45° FOV; 2352 by 1568 pixels.
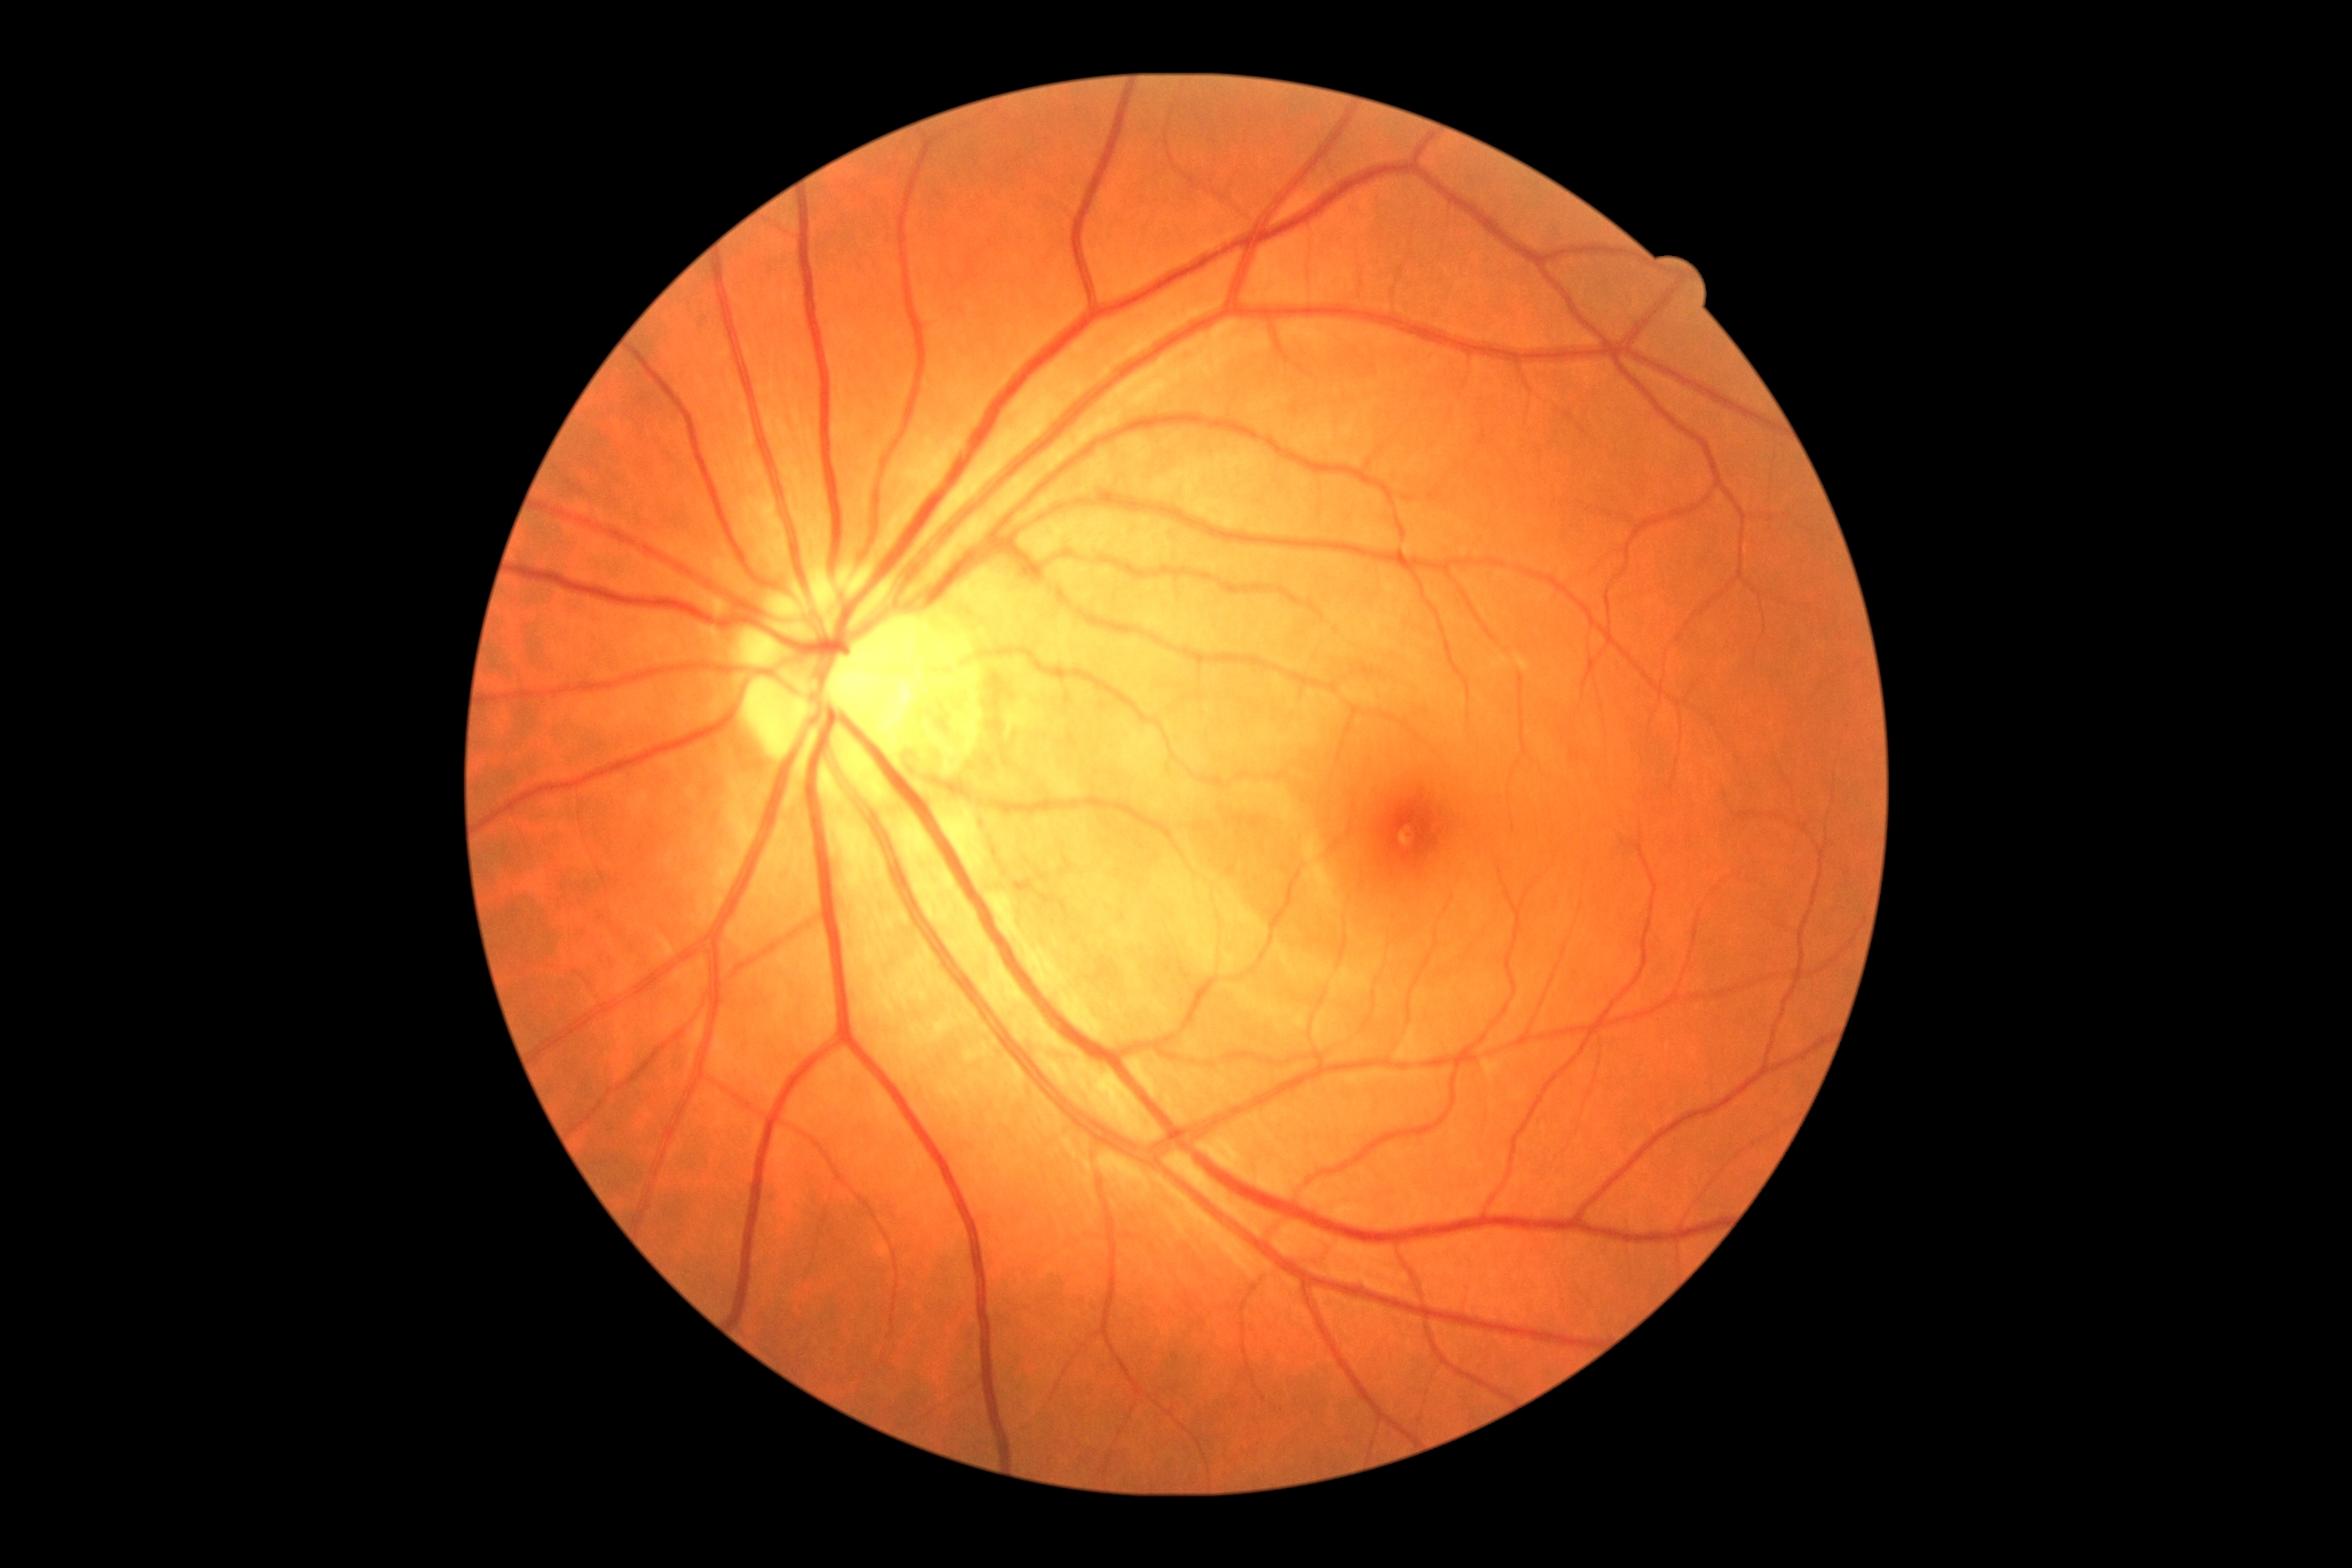
DR grade: 0 — no visible signs of diabetic retinopathy; DR impression: no DR findings.